Color fundus photograph. FOV: 45 degrees.
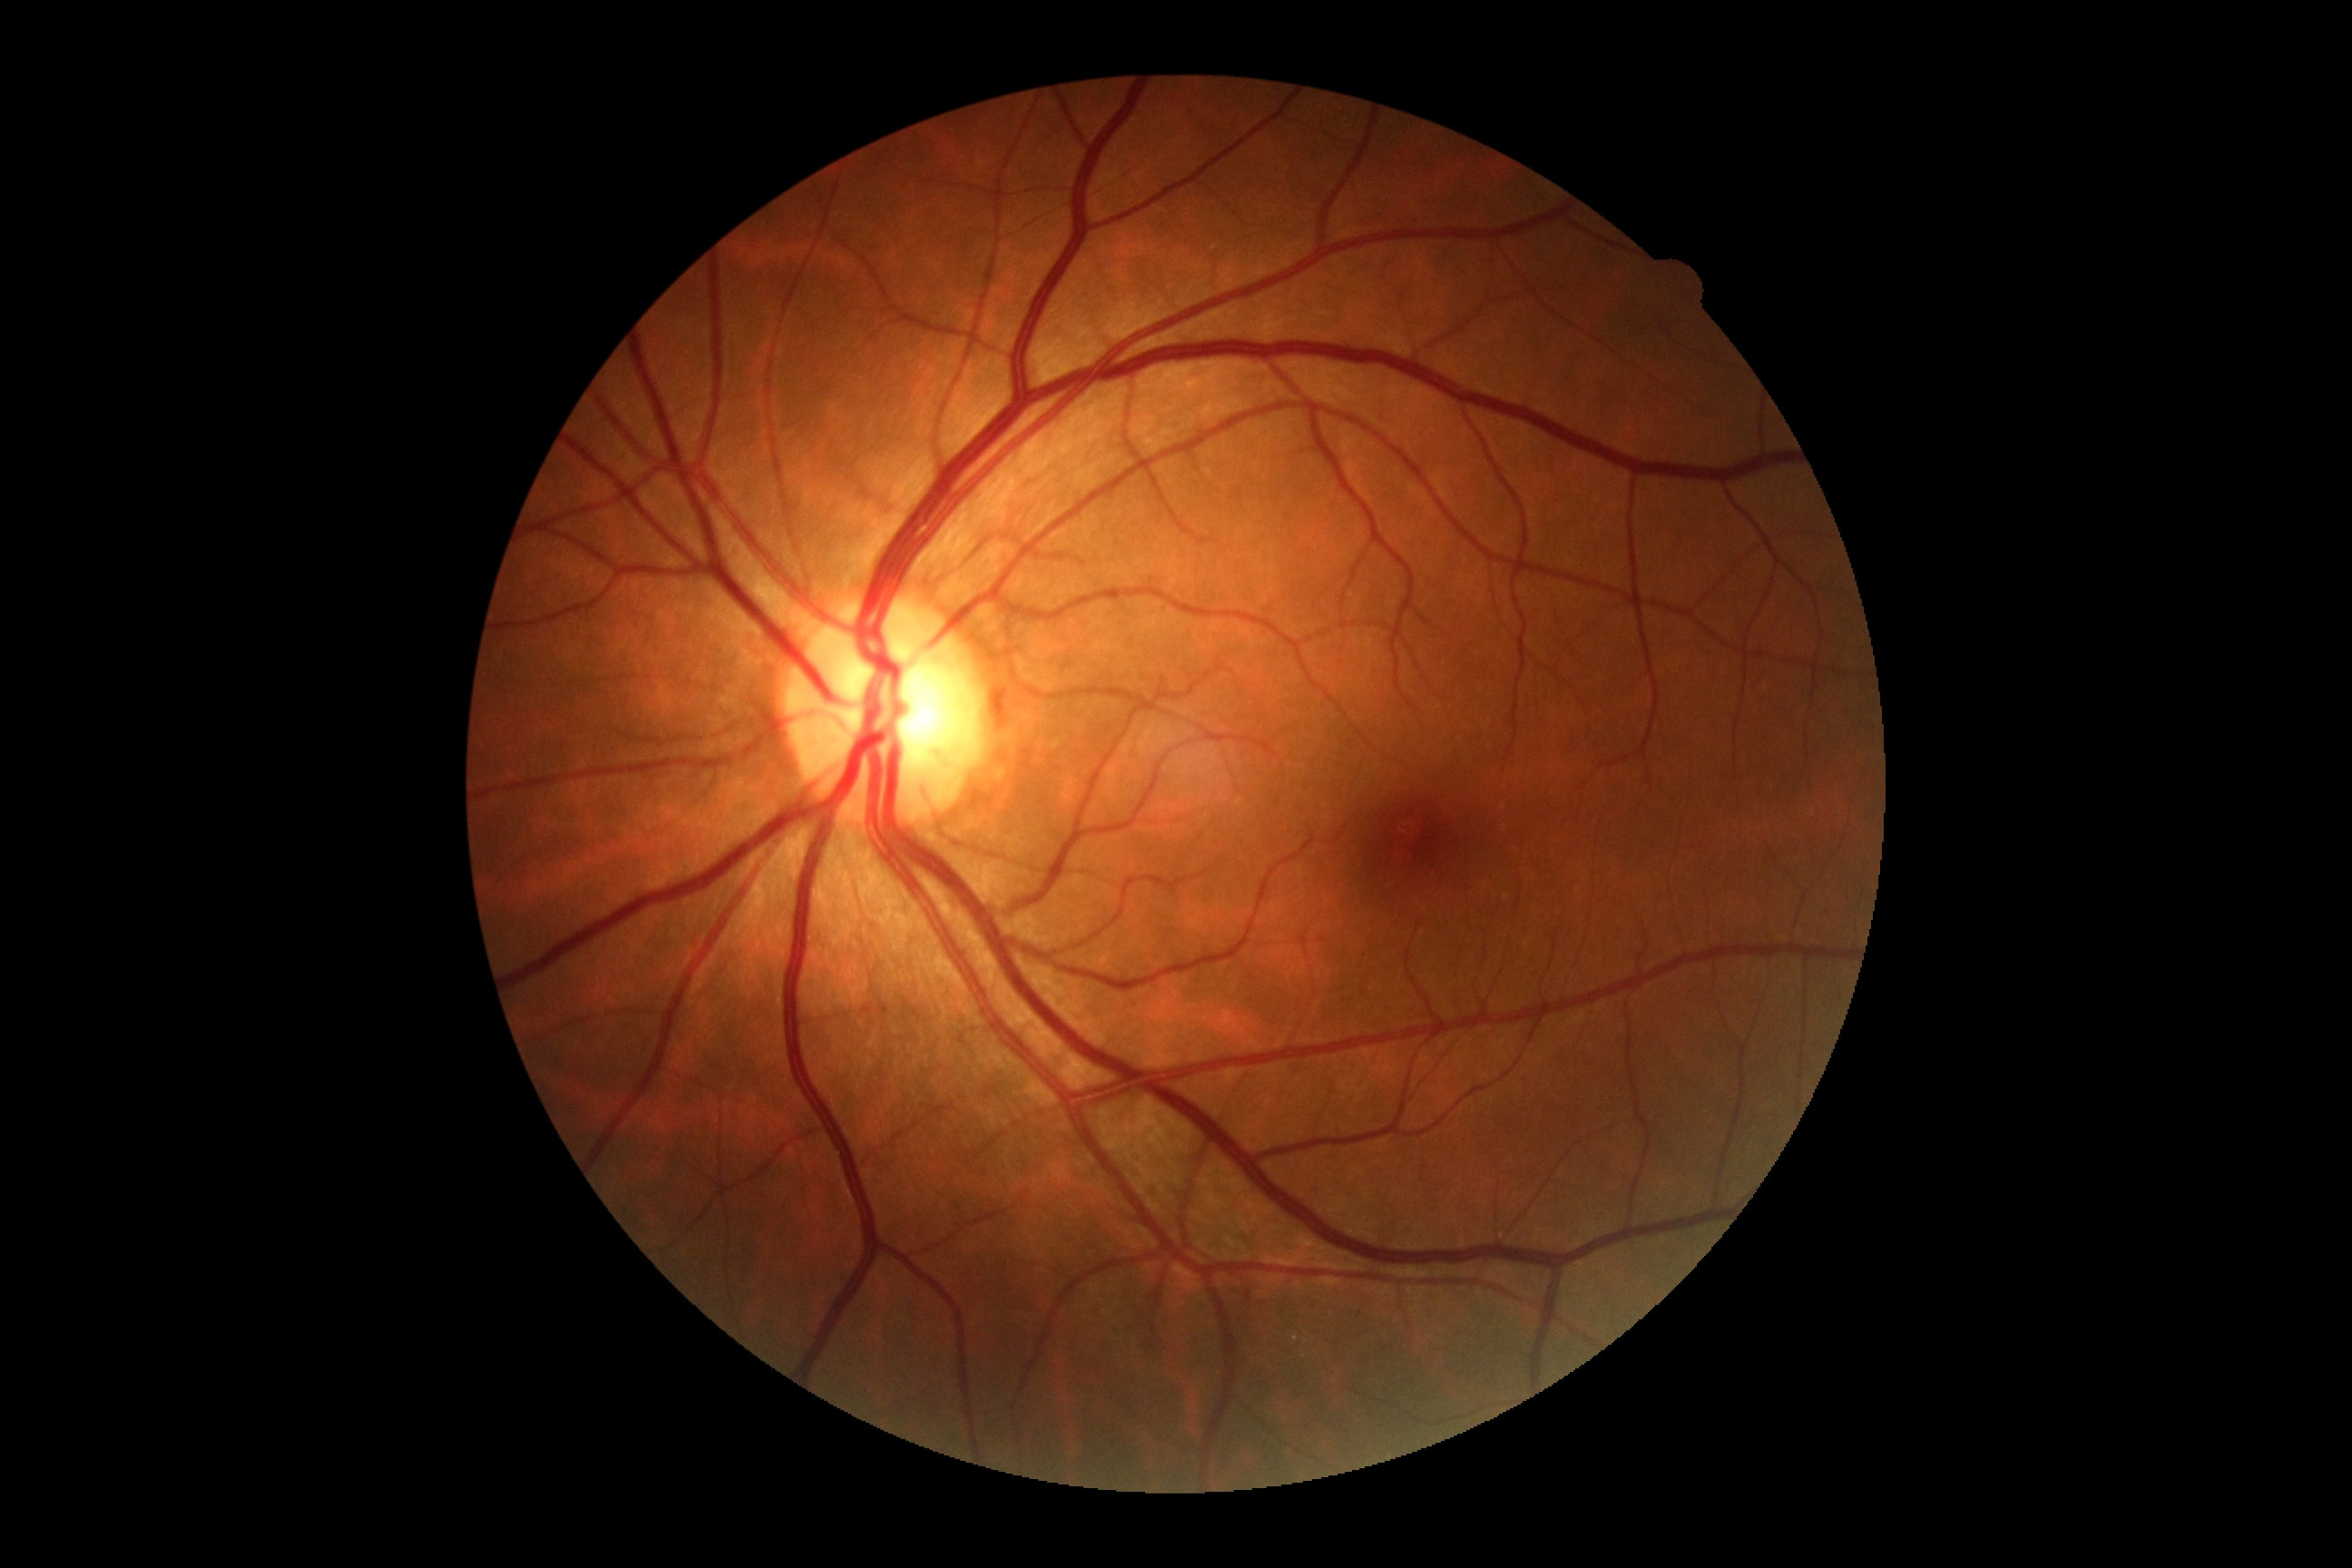

Diabetic retinopathy severity is no apparent retinopathy (grade 0).